2352 x 1568 pixels — 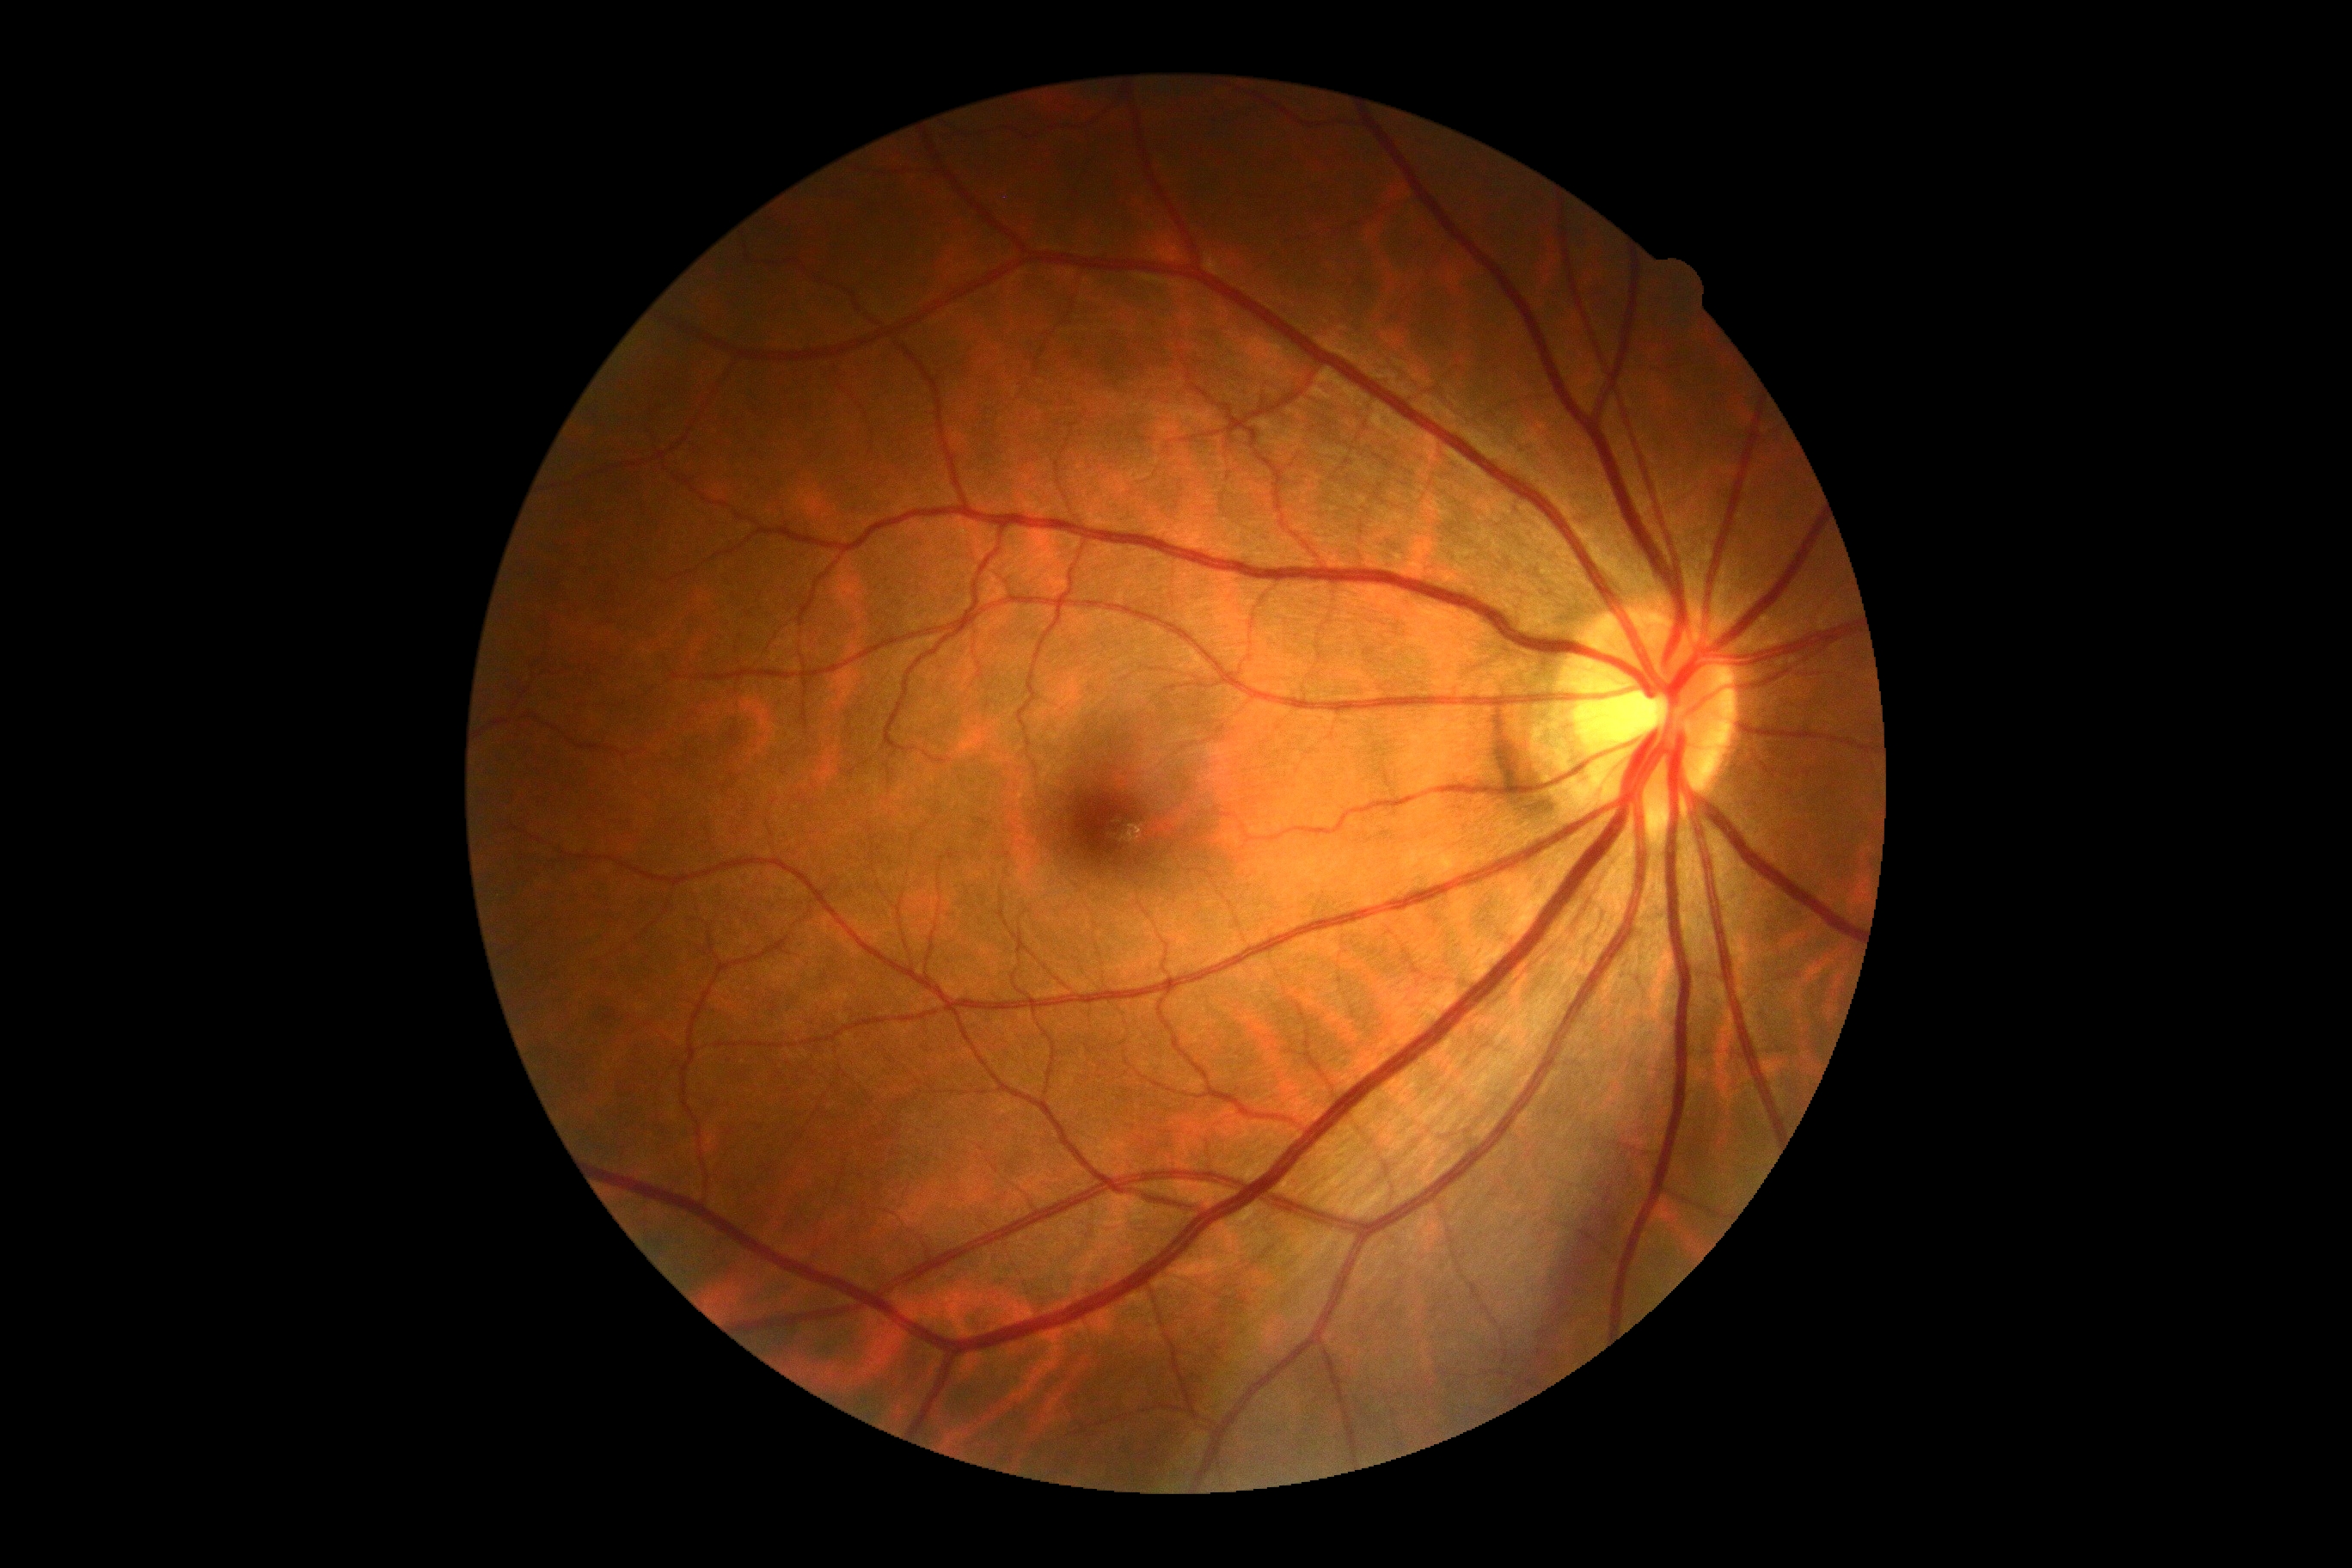 Diabetic retinopathy: grade 0.